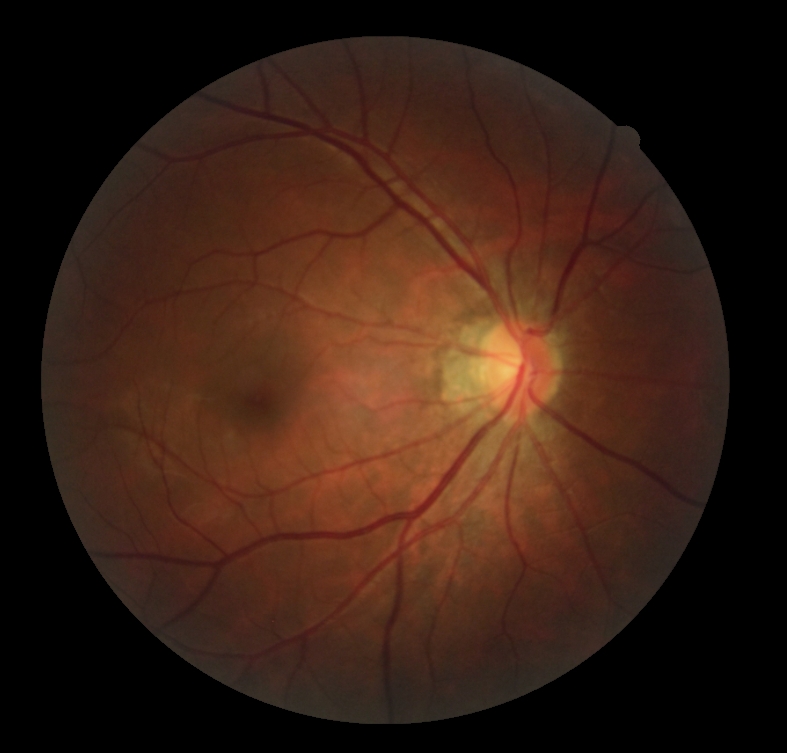
DR severity: 0, DR impression: no signs of DR.